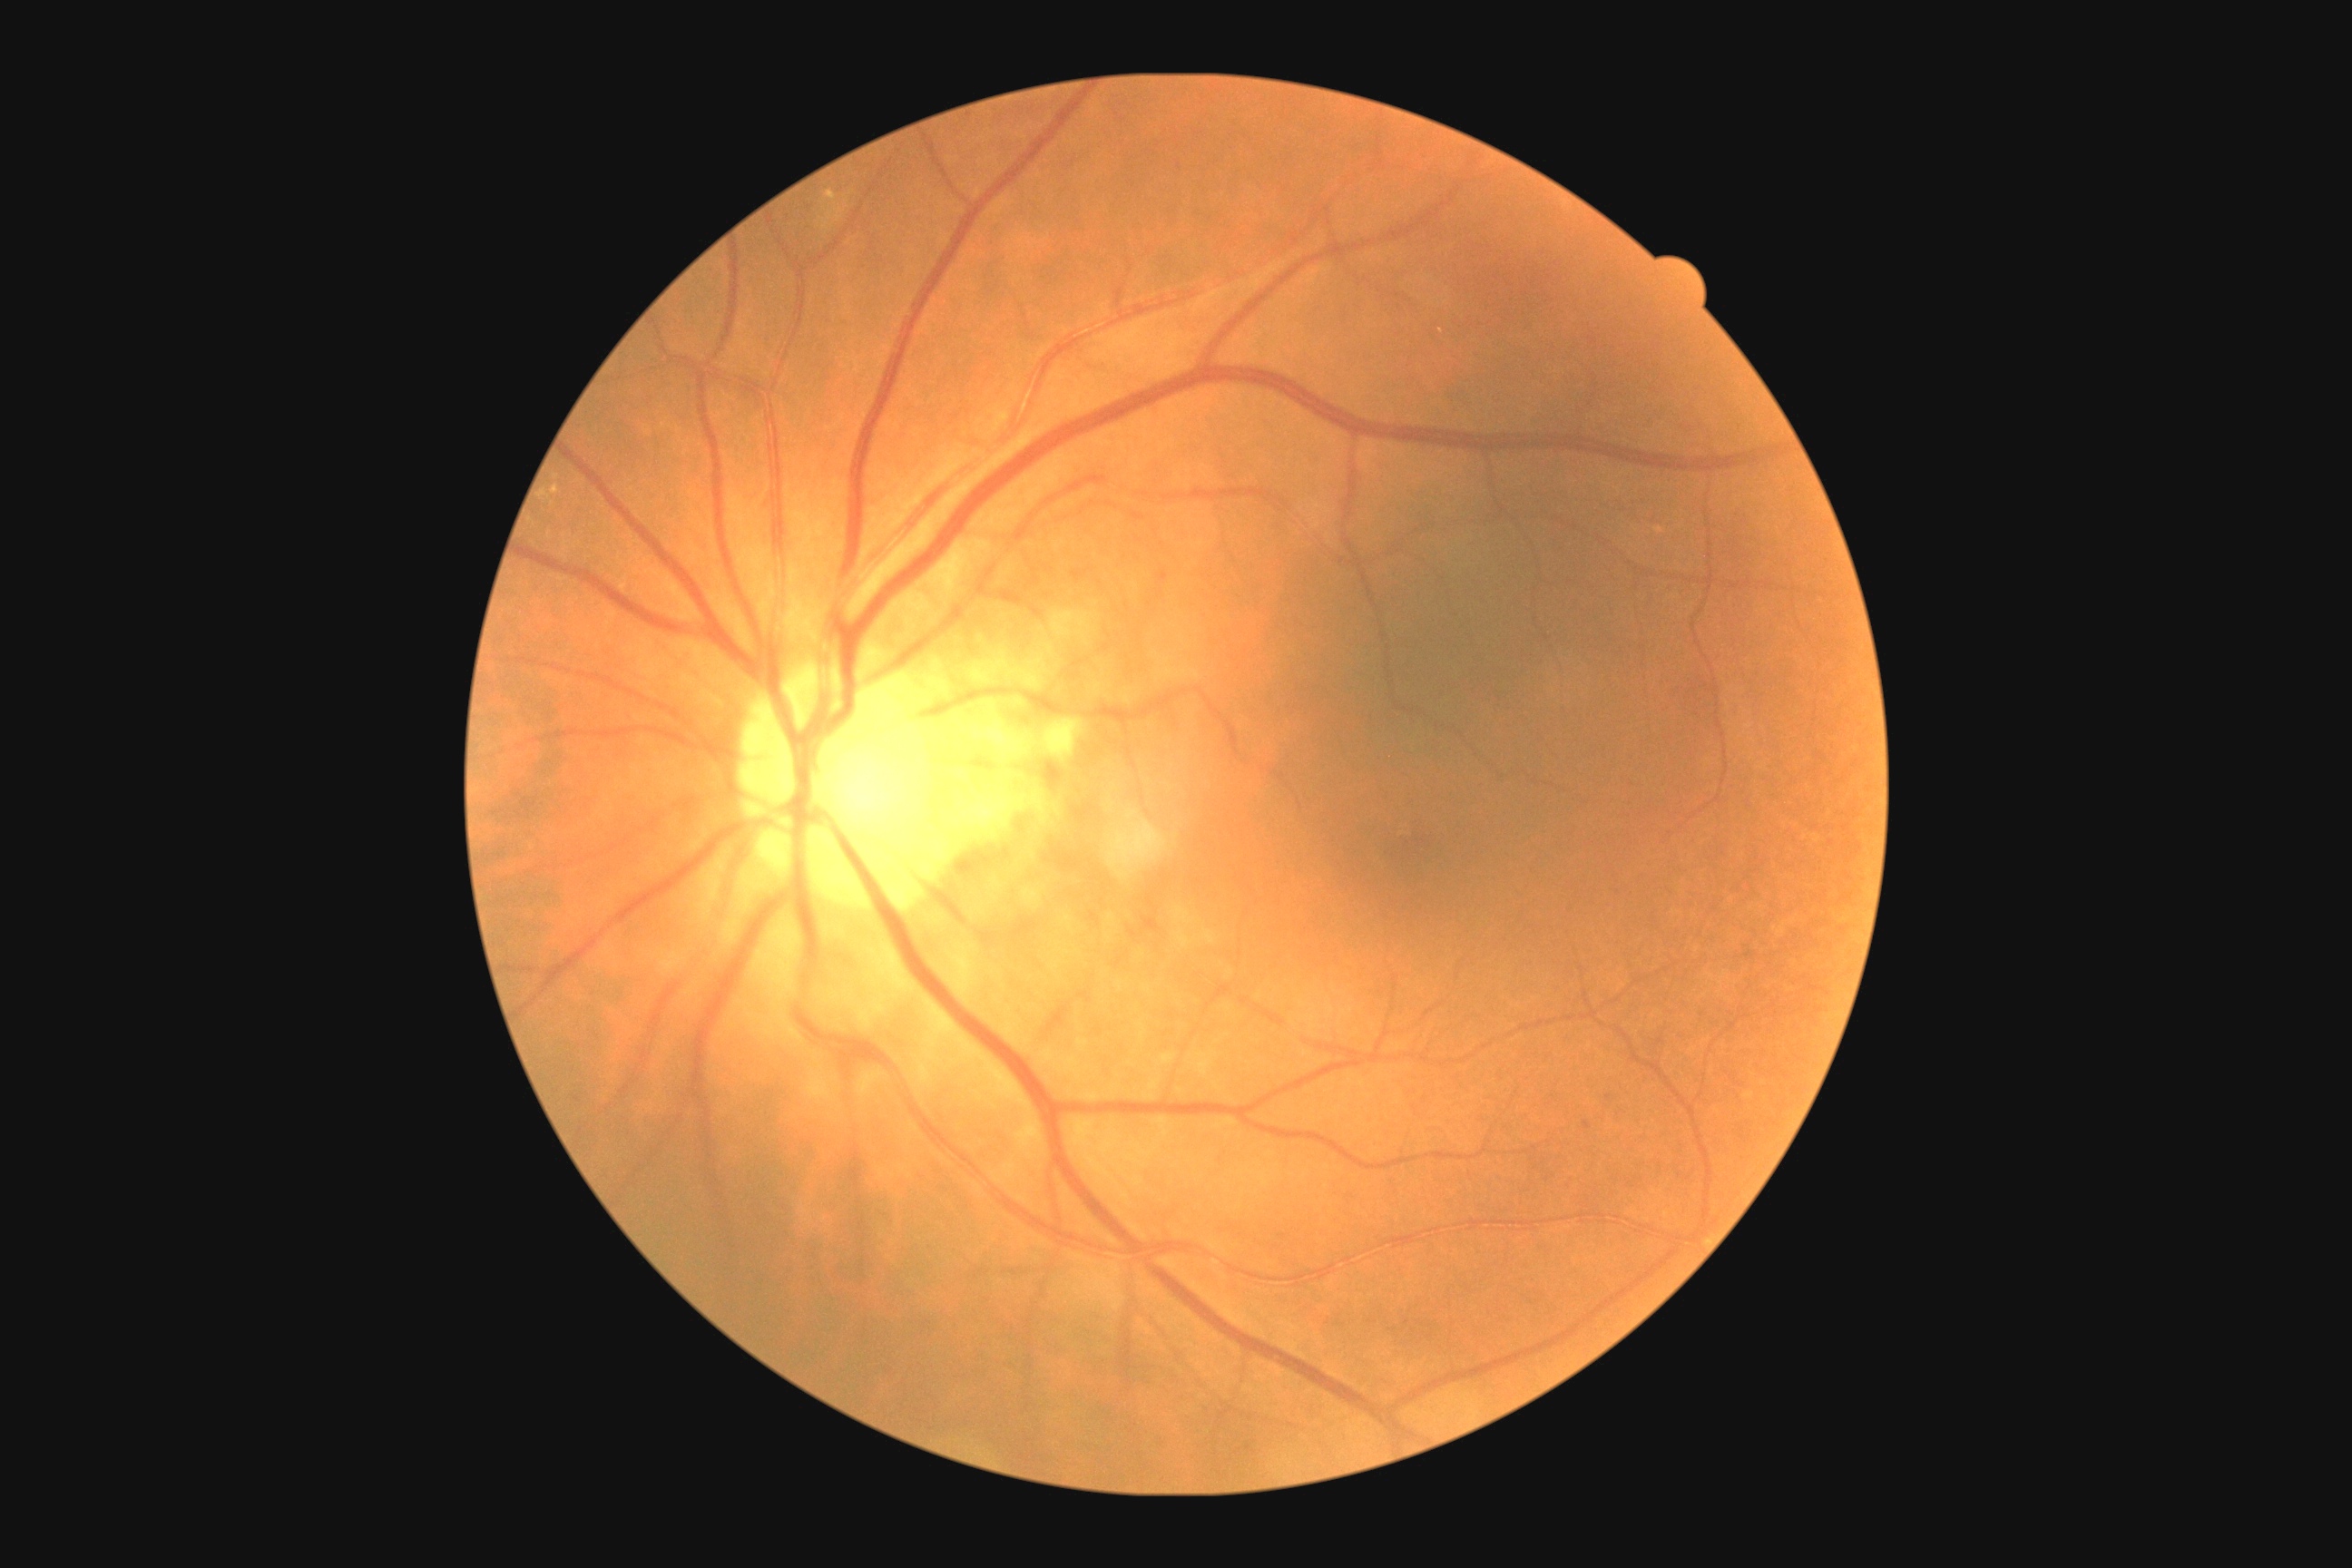

DR@2/4.